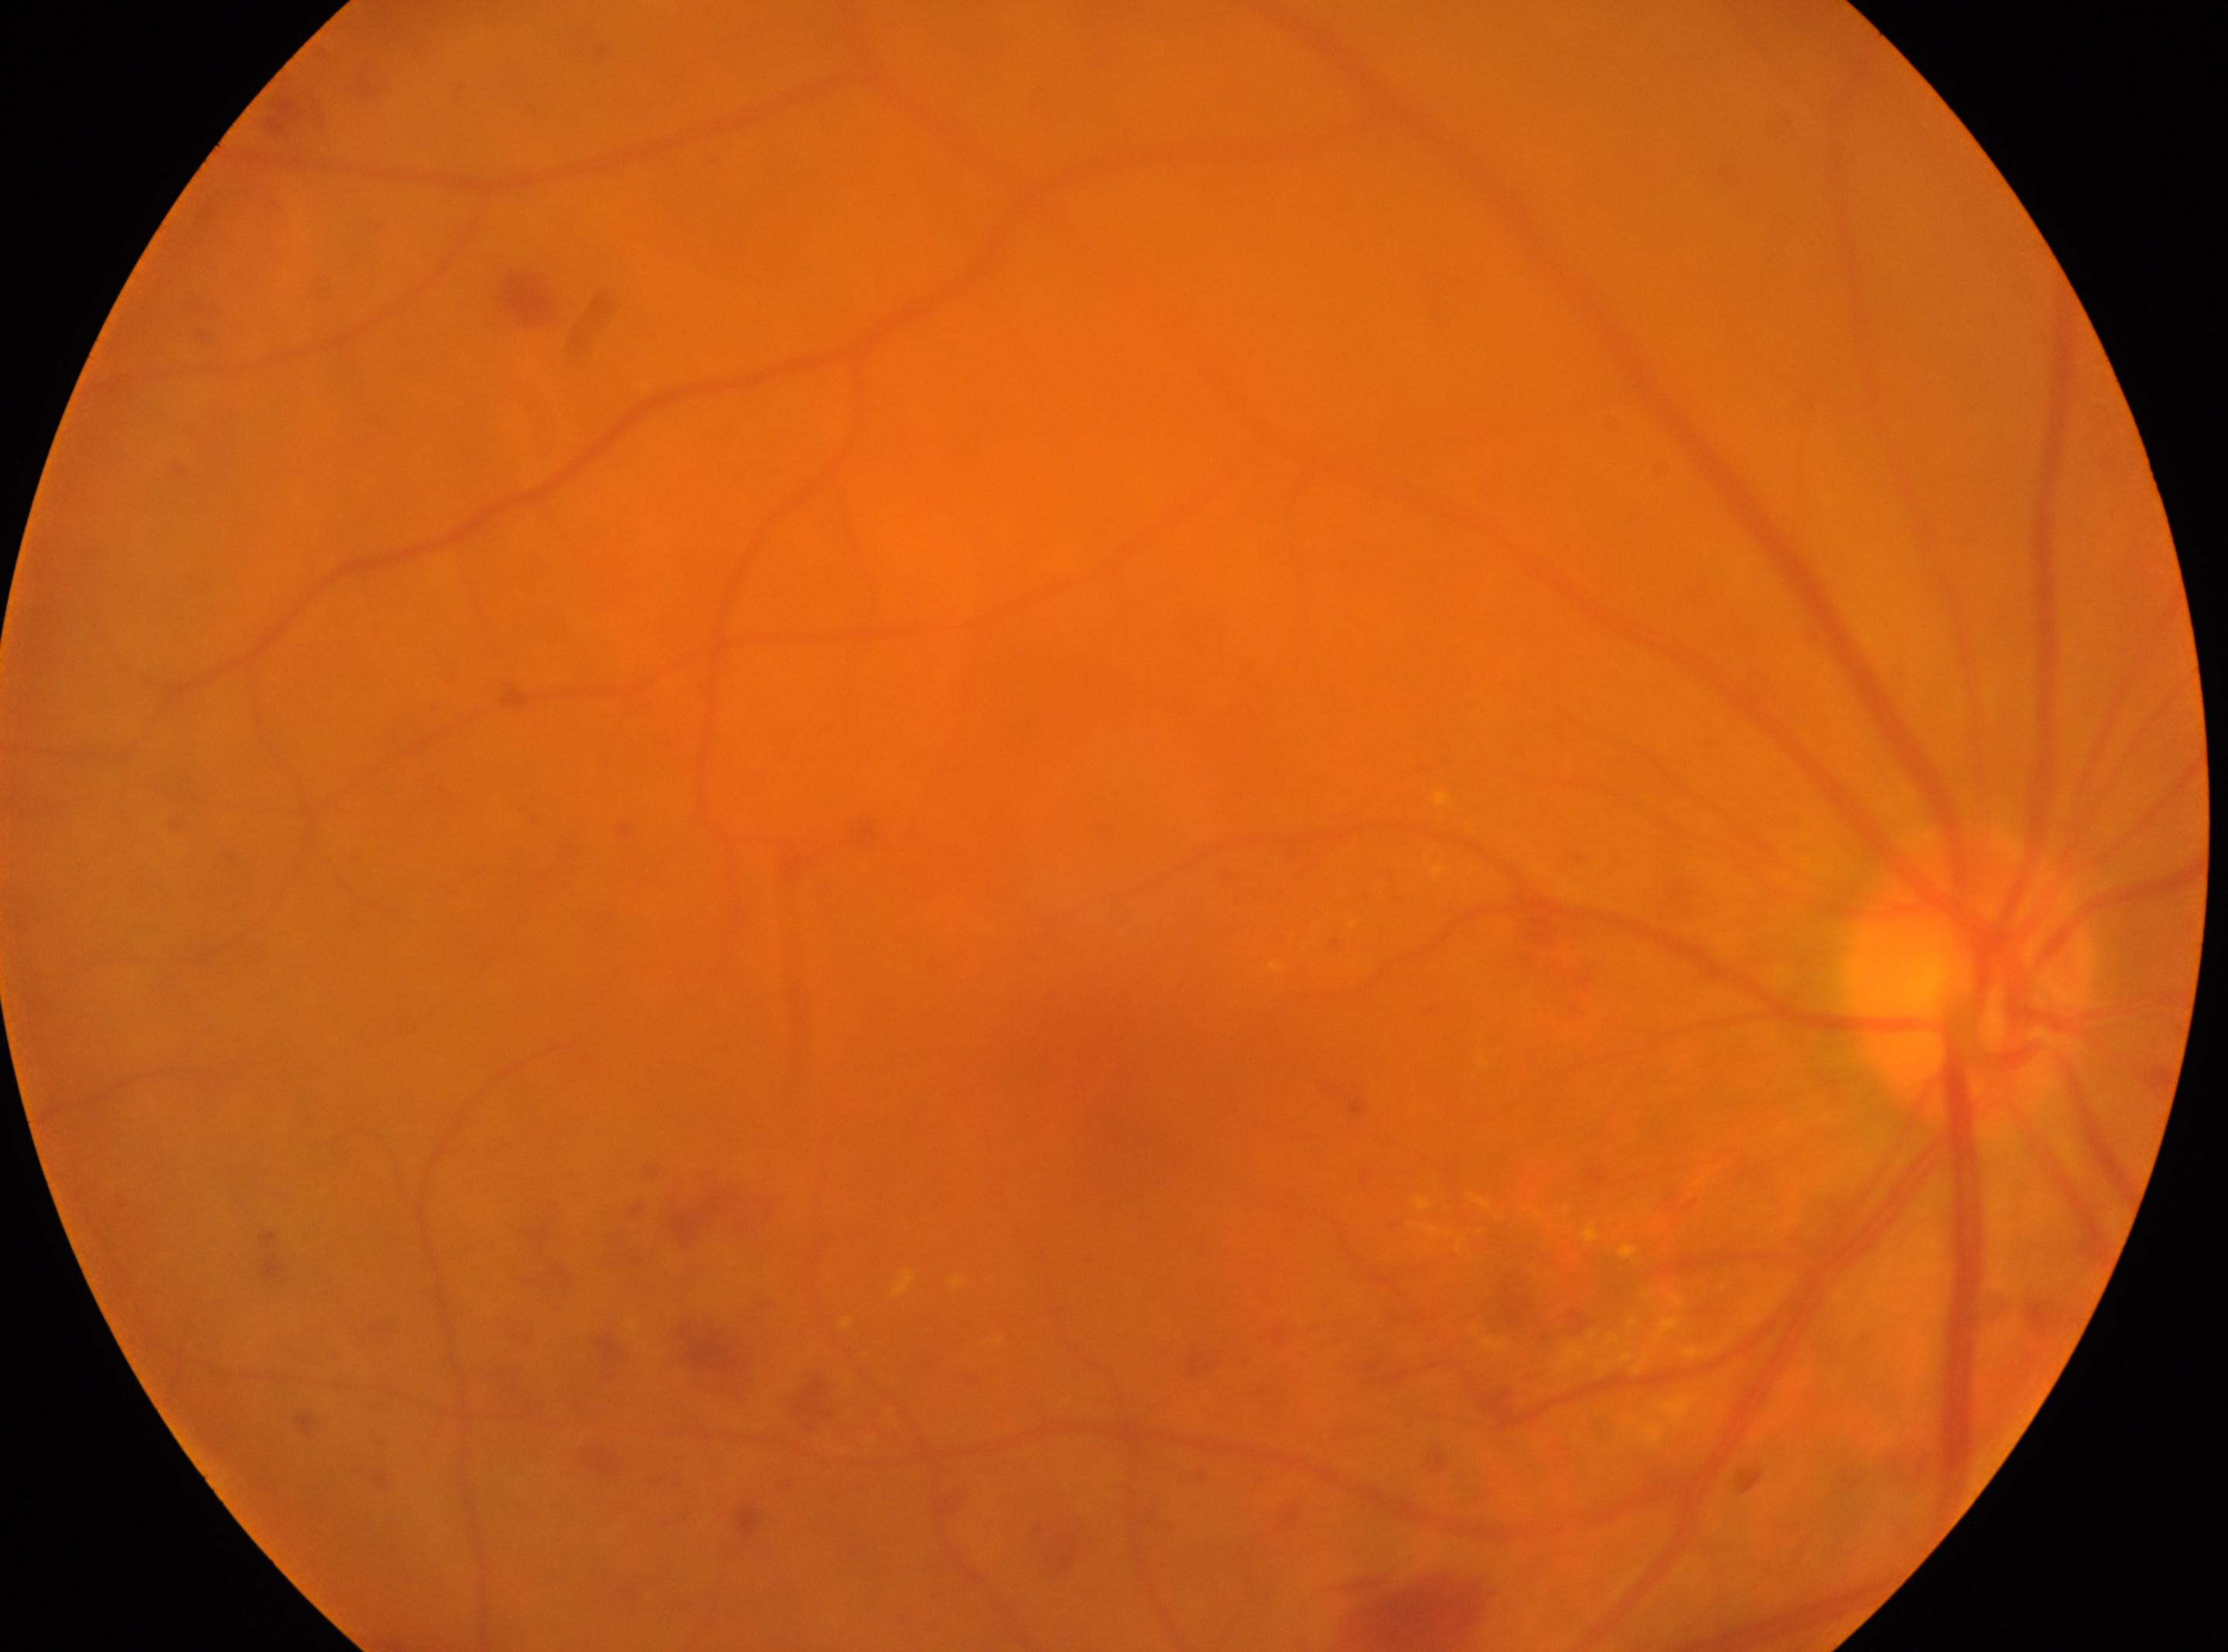
* ONH · (1966,979)
* fovea centralis · (1122,1135)
* DR · moderate non-proliferative diabetic retinopathy (grade 2)
* laterality · the right eye